Optic nerve head photograph · dilated pupil — 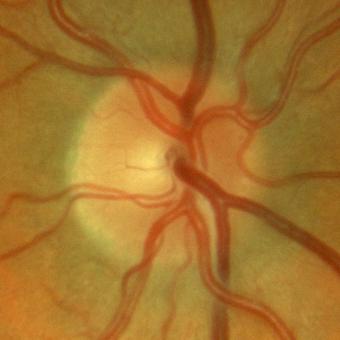 Glaucoma assessment: no evidence of glaucoma.